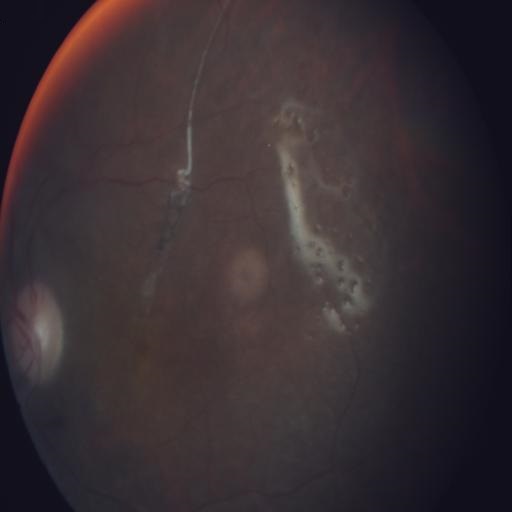 This fundus photograph shows retinal traction (RT).